45 degree fundus photograph · color fundus photograph.
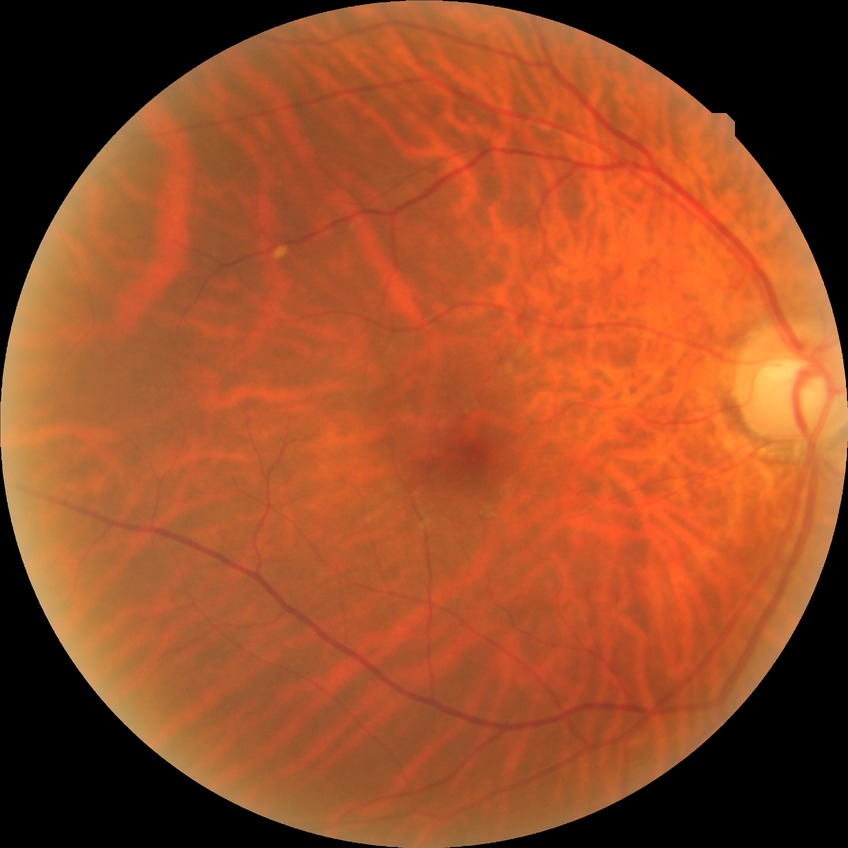 Assessment:
• diabetic retinopathy grade: no diabetic retinopathy